Fundus photo
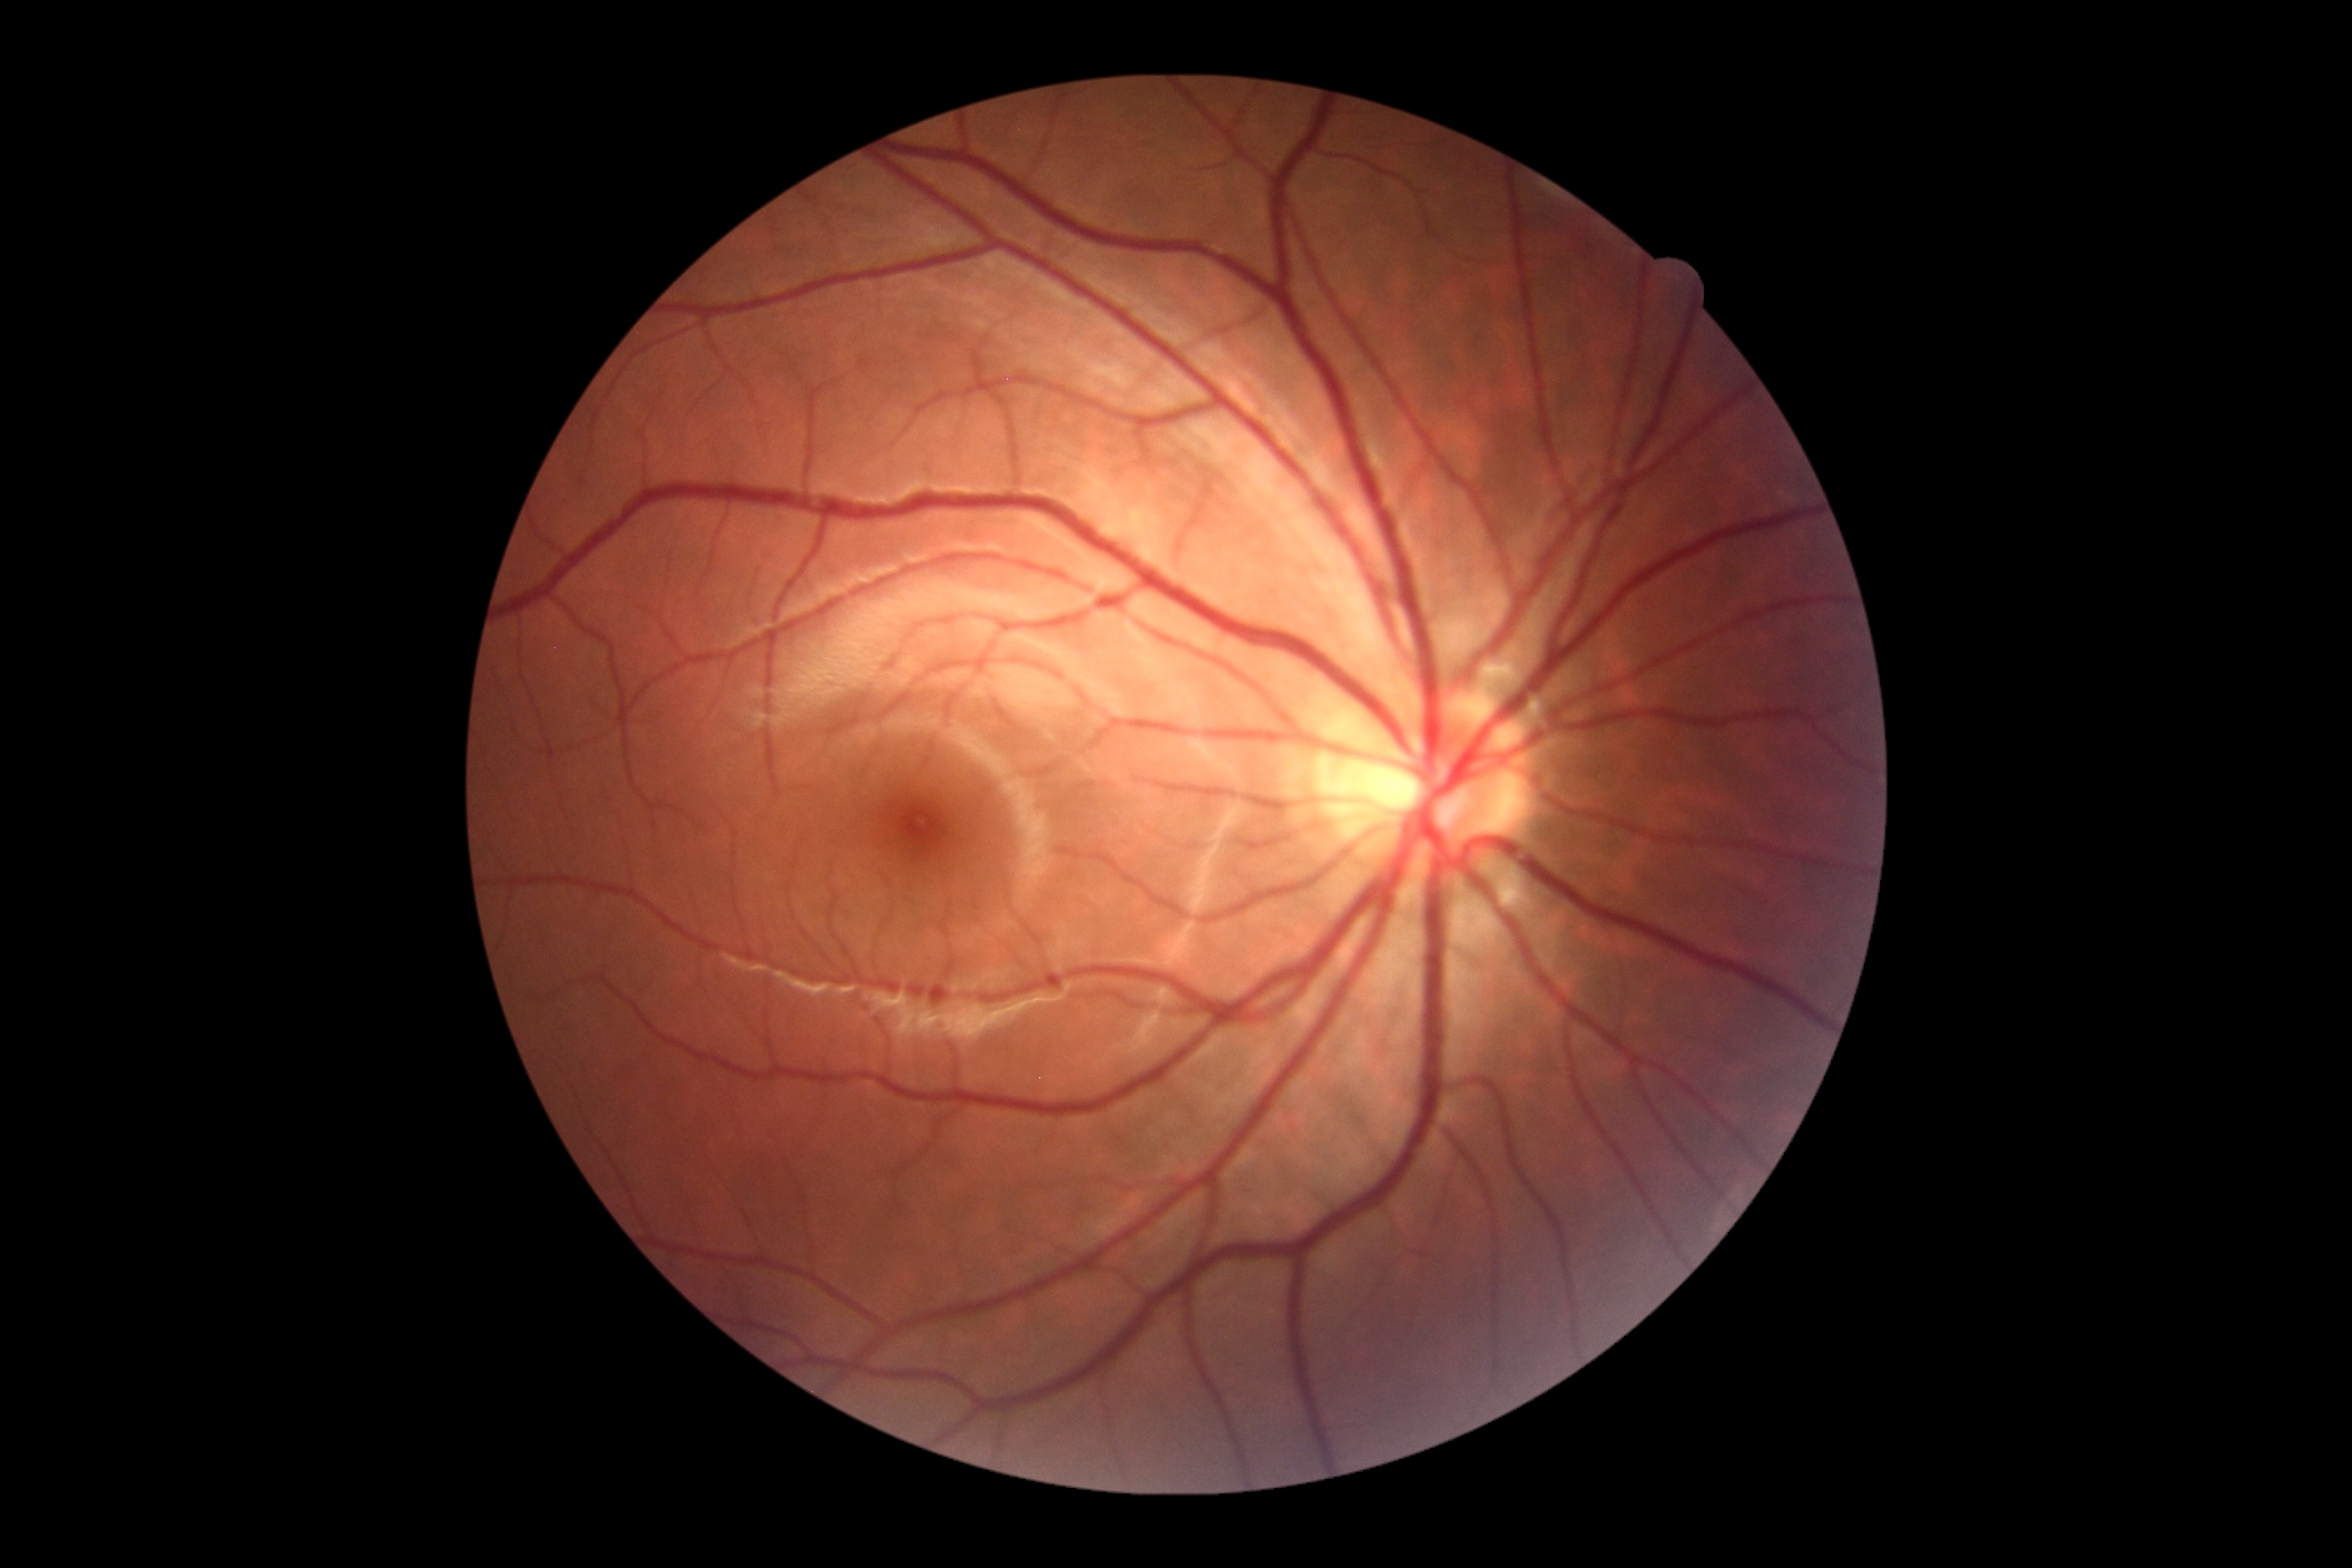
retinopathy grade: 0/4 — no visible signs of diabetic retinopathy; DR impression: negative for DR.